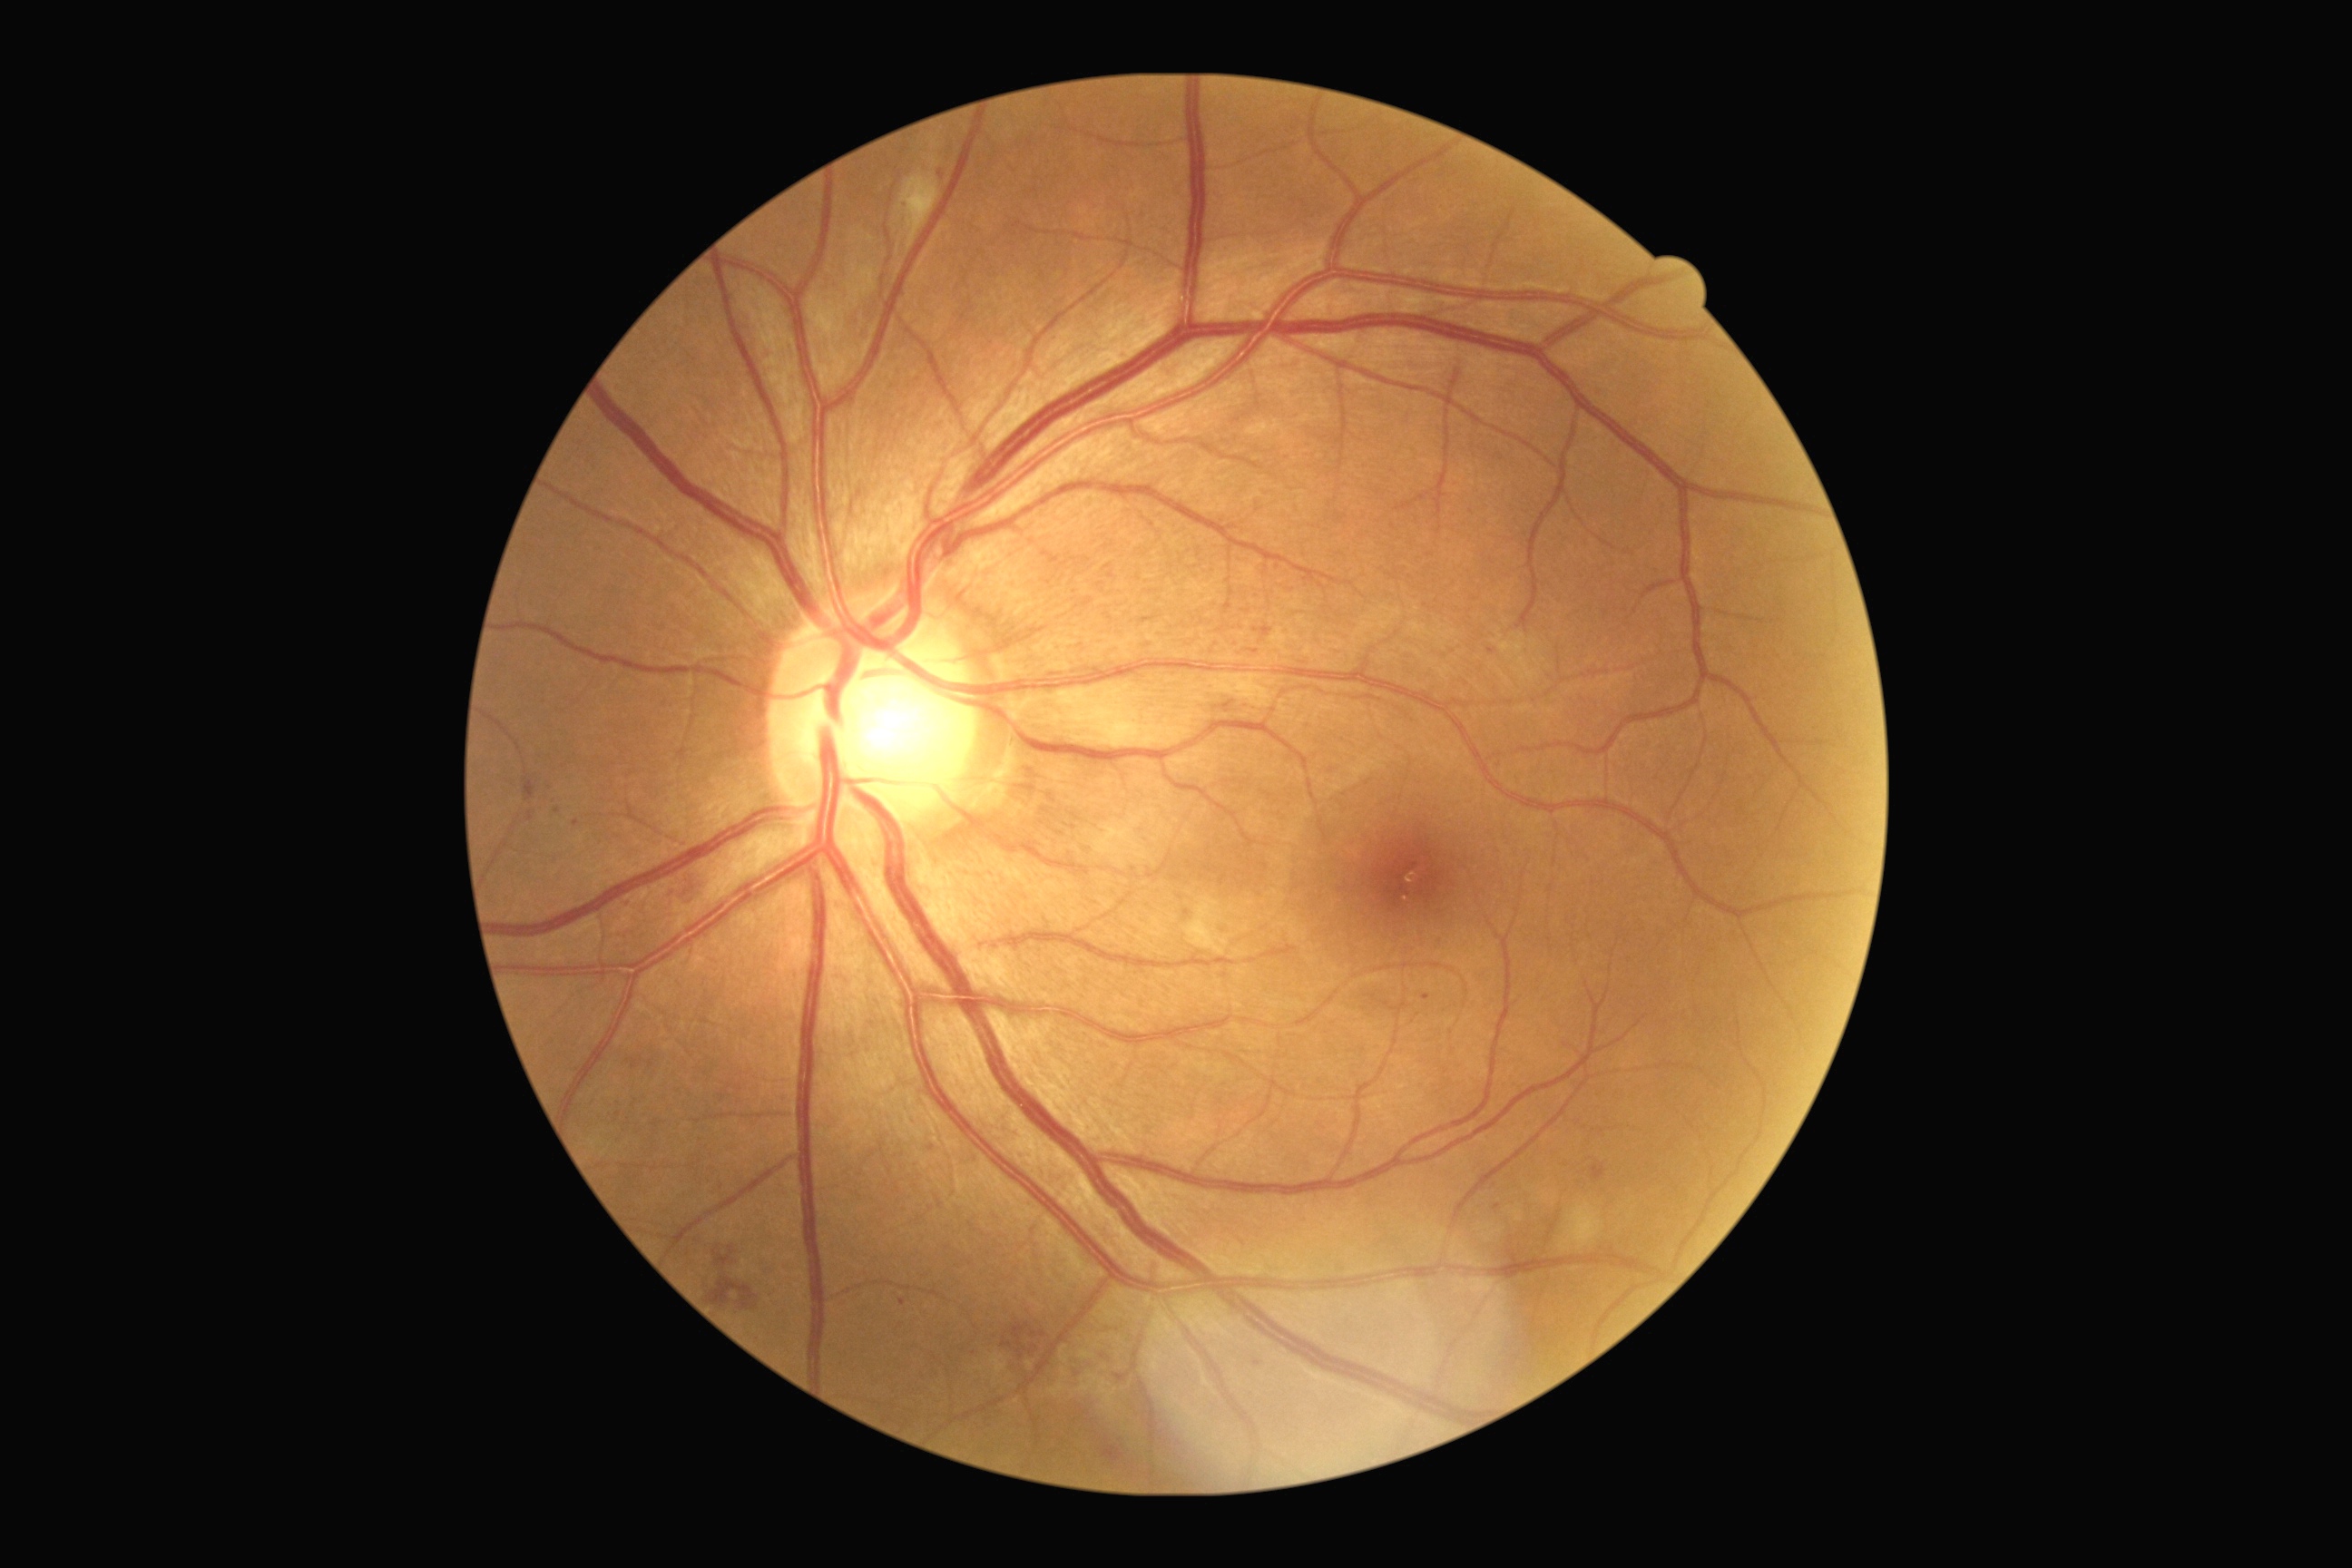
DR stage: moderate NPDR (grade 2)